45° FOV: 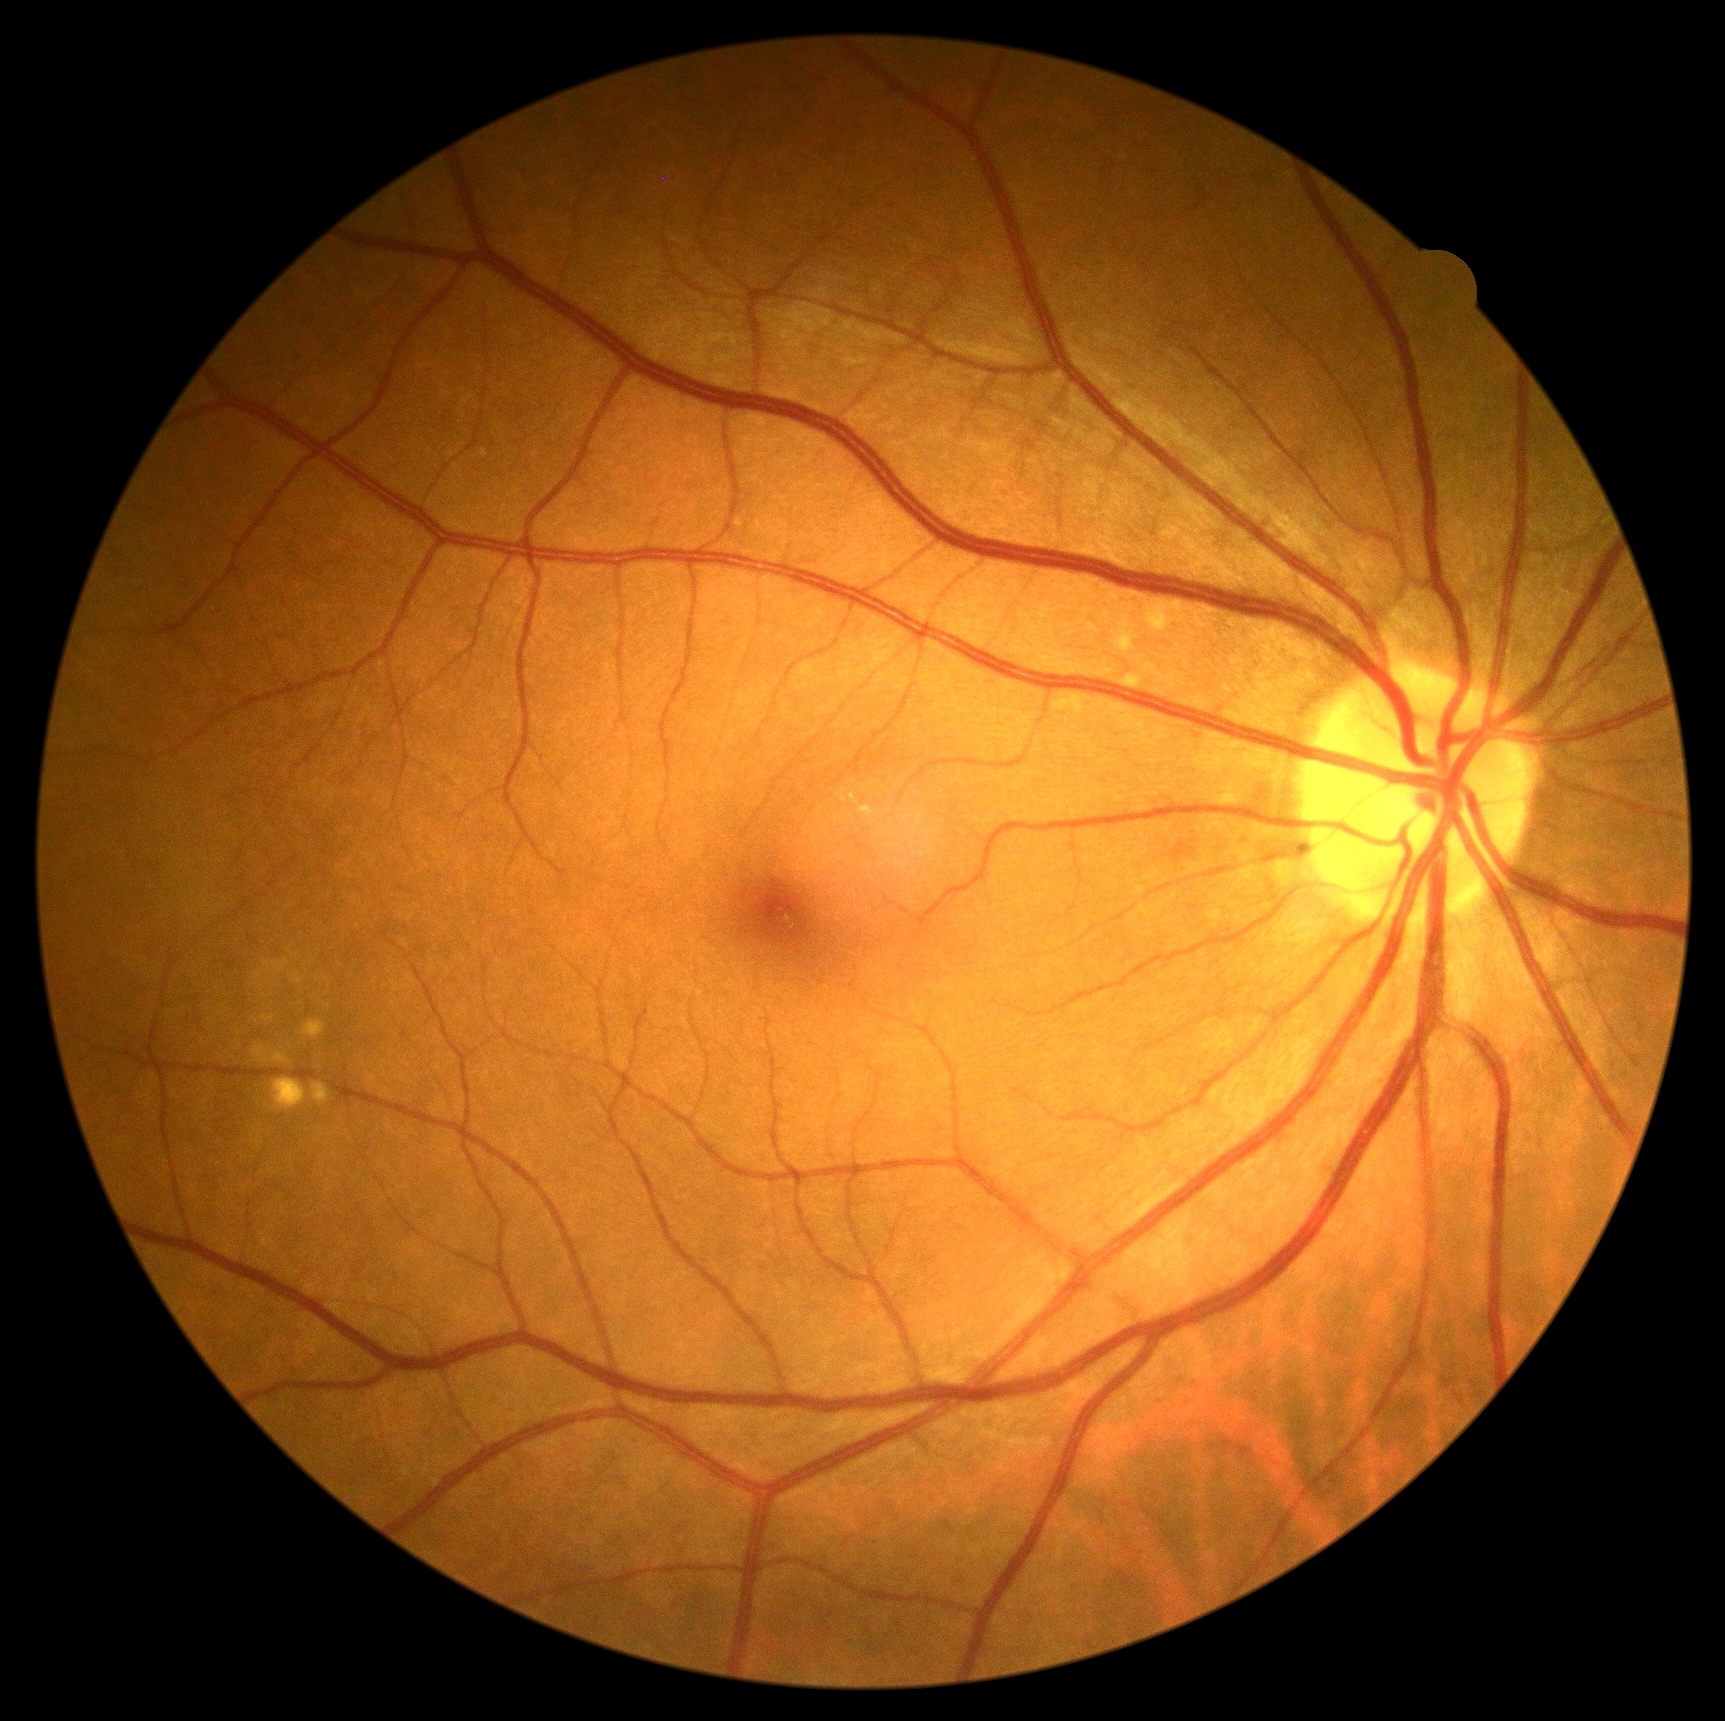
Findings:
* diabetic retinopathy — no apparent diabetic retinopathy (grade 0) — no visible signs of diabetic retinopathy